Color fundus image.
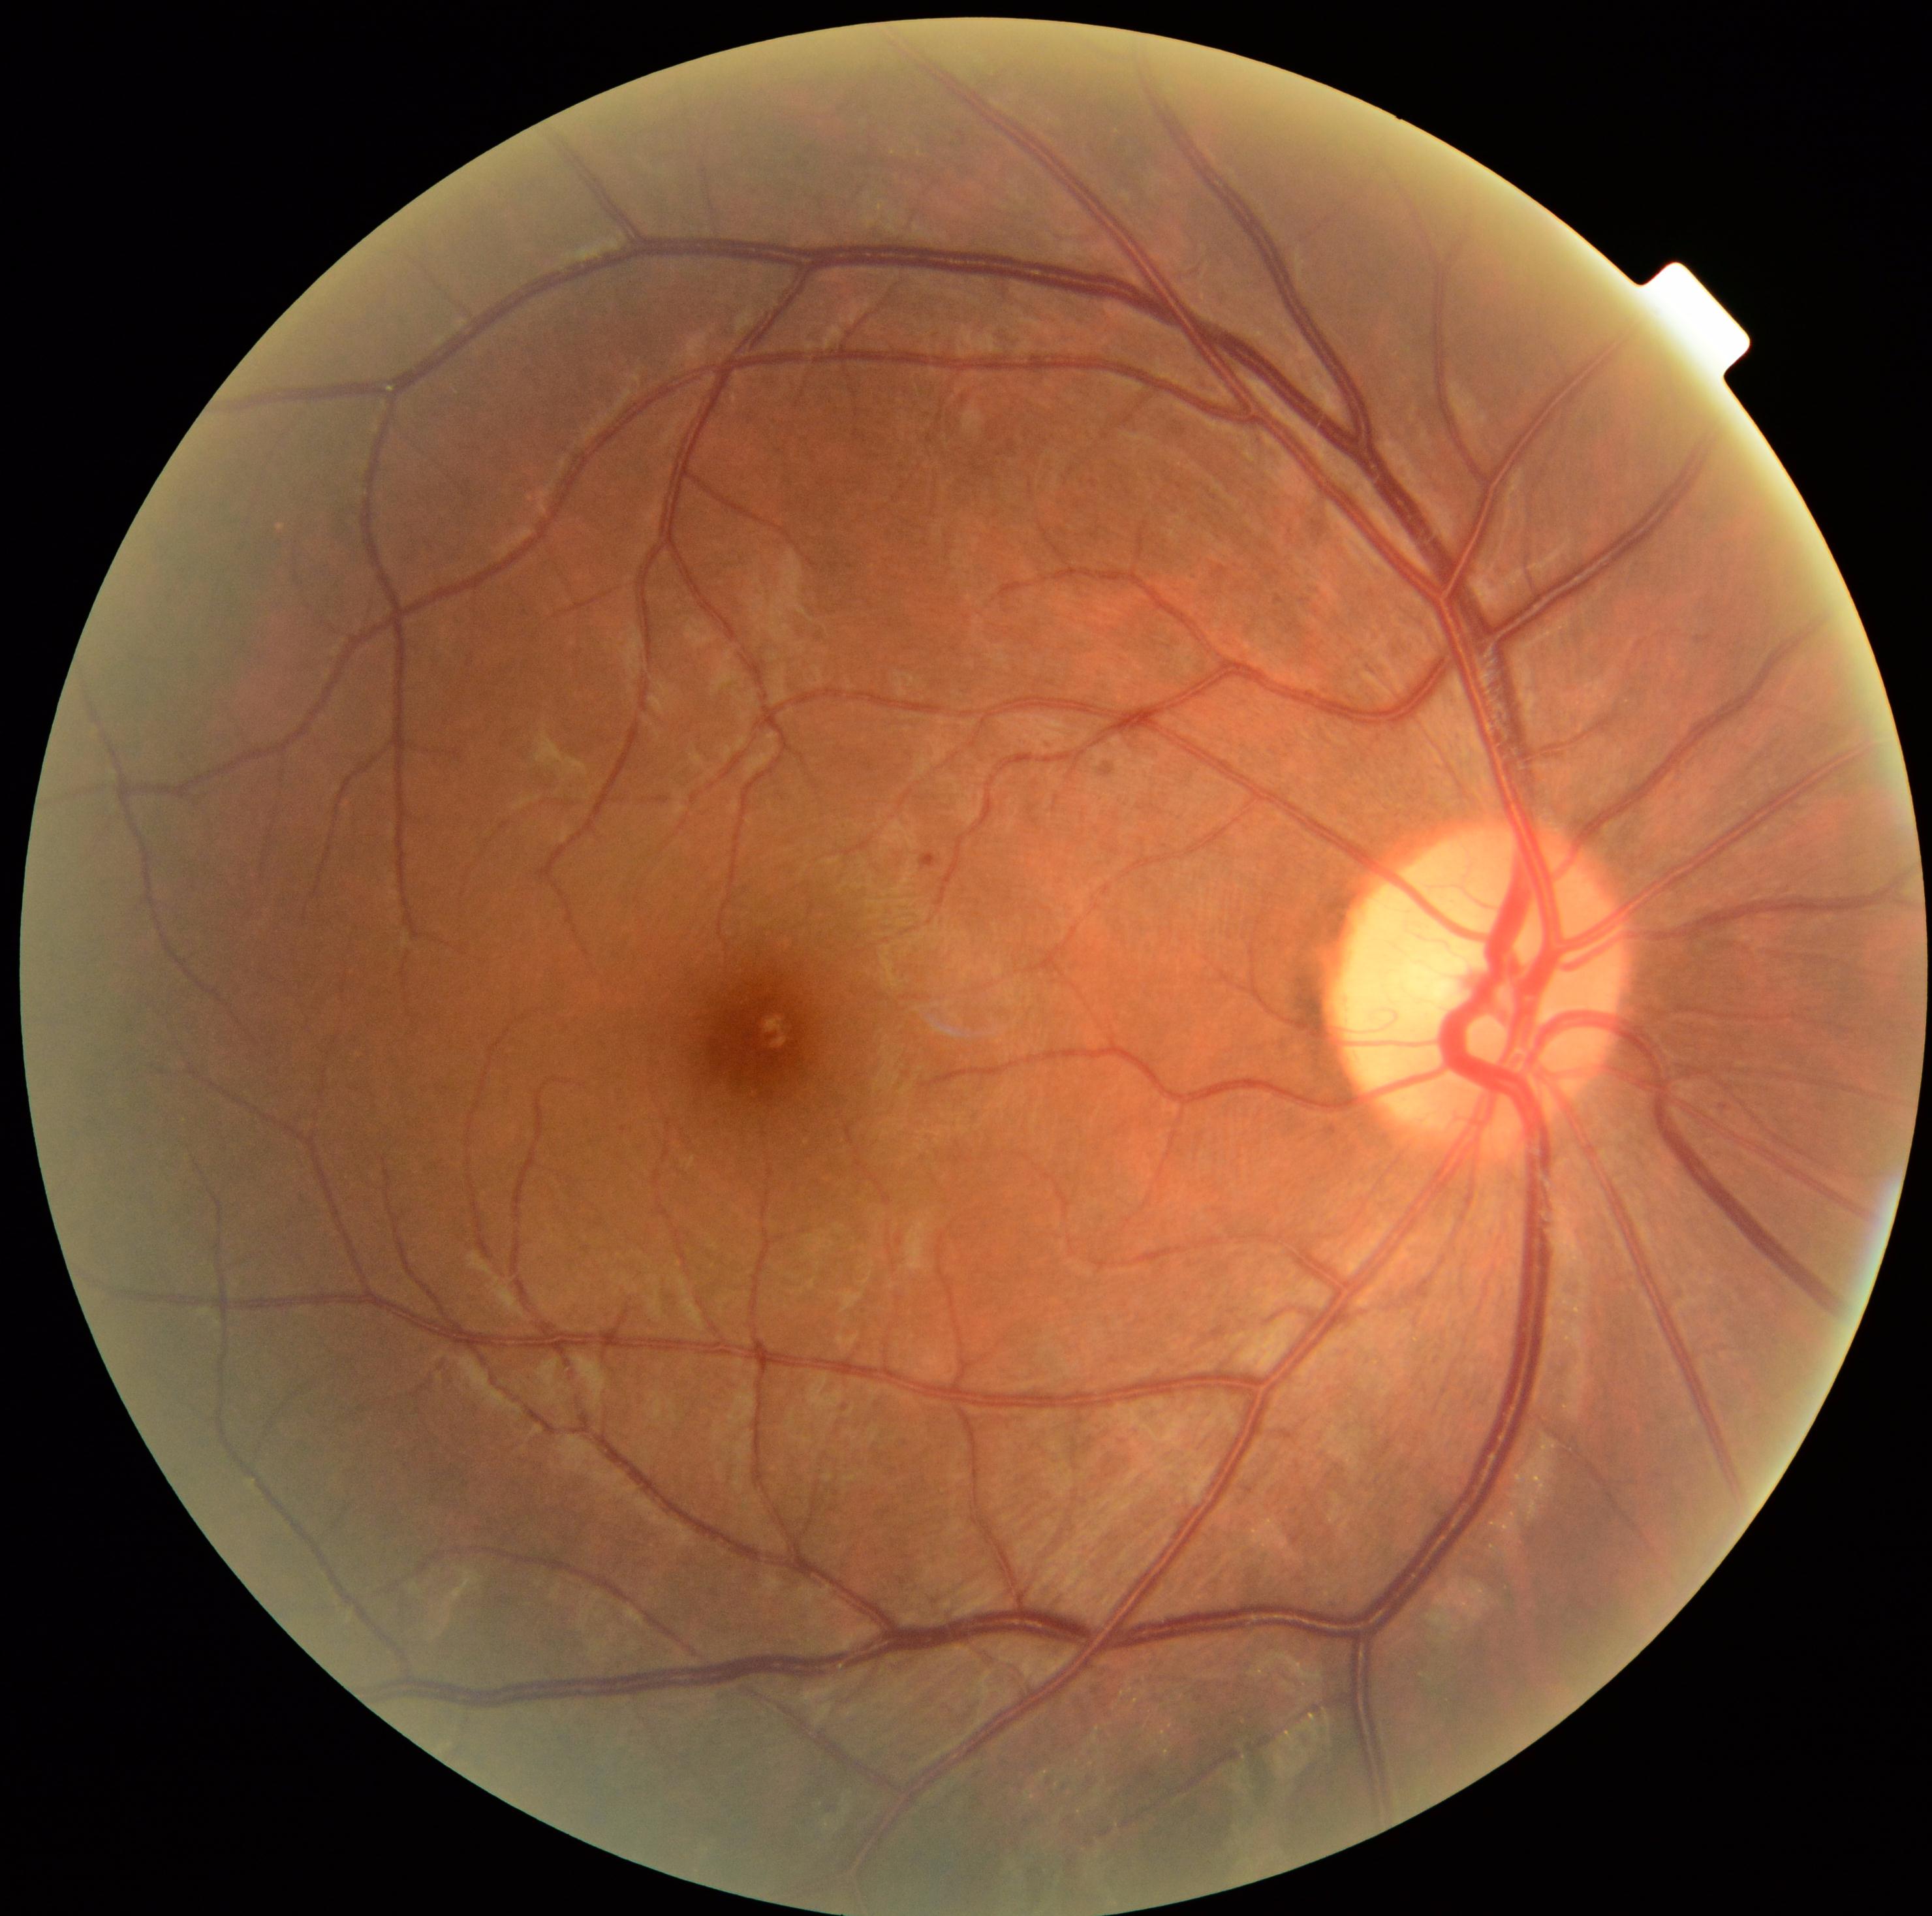
partial: true
dr_grade: 1
dr_grade_name: mild NPDR
lesions:
  se: []
  ex: []
  ma:
    - region(921, 854, 939, 870)
  he: []